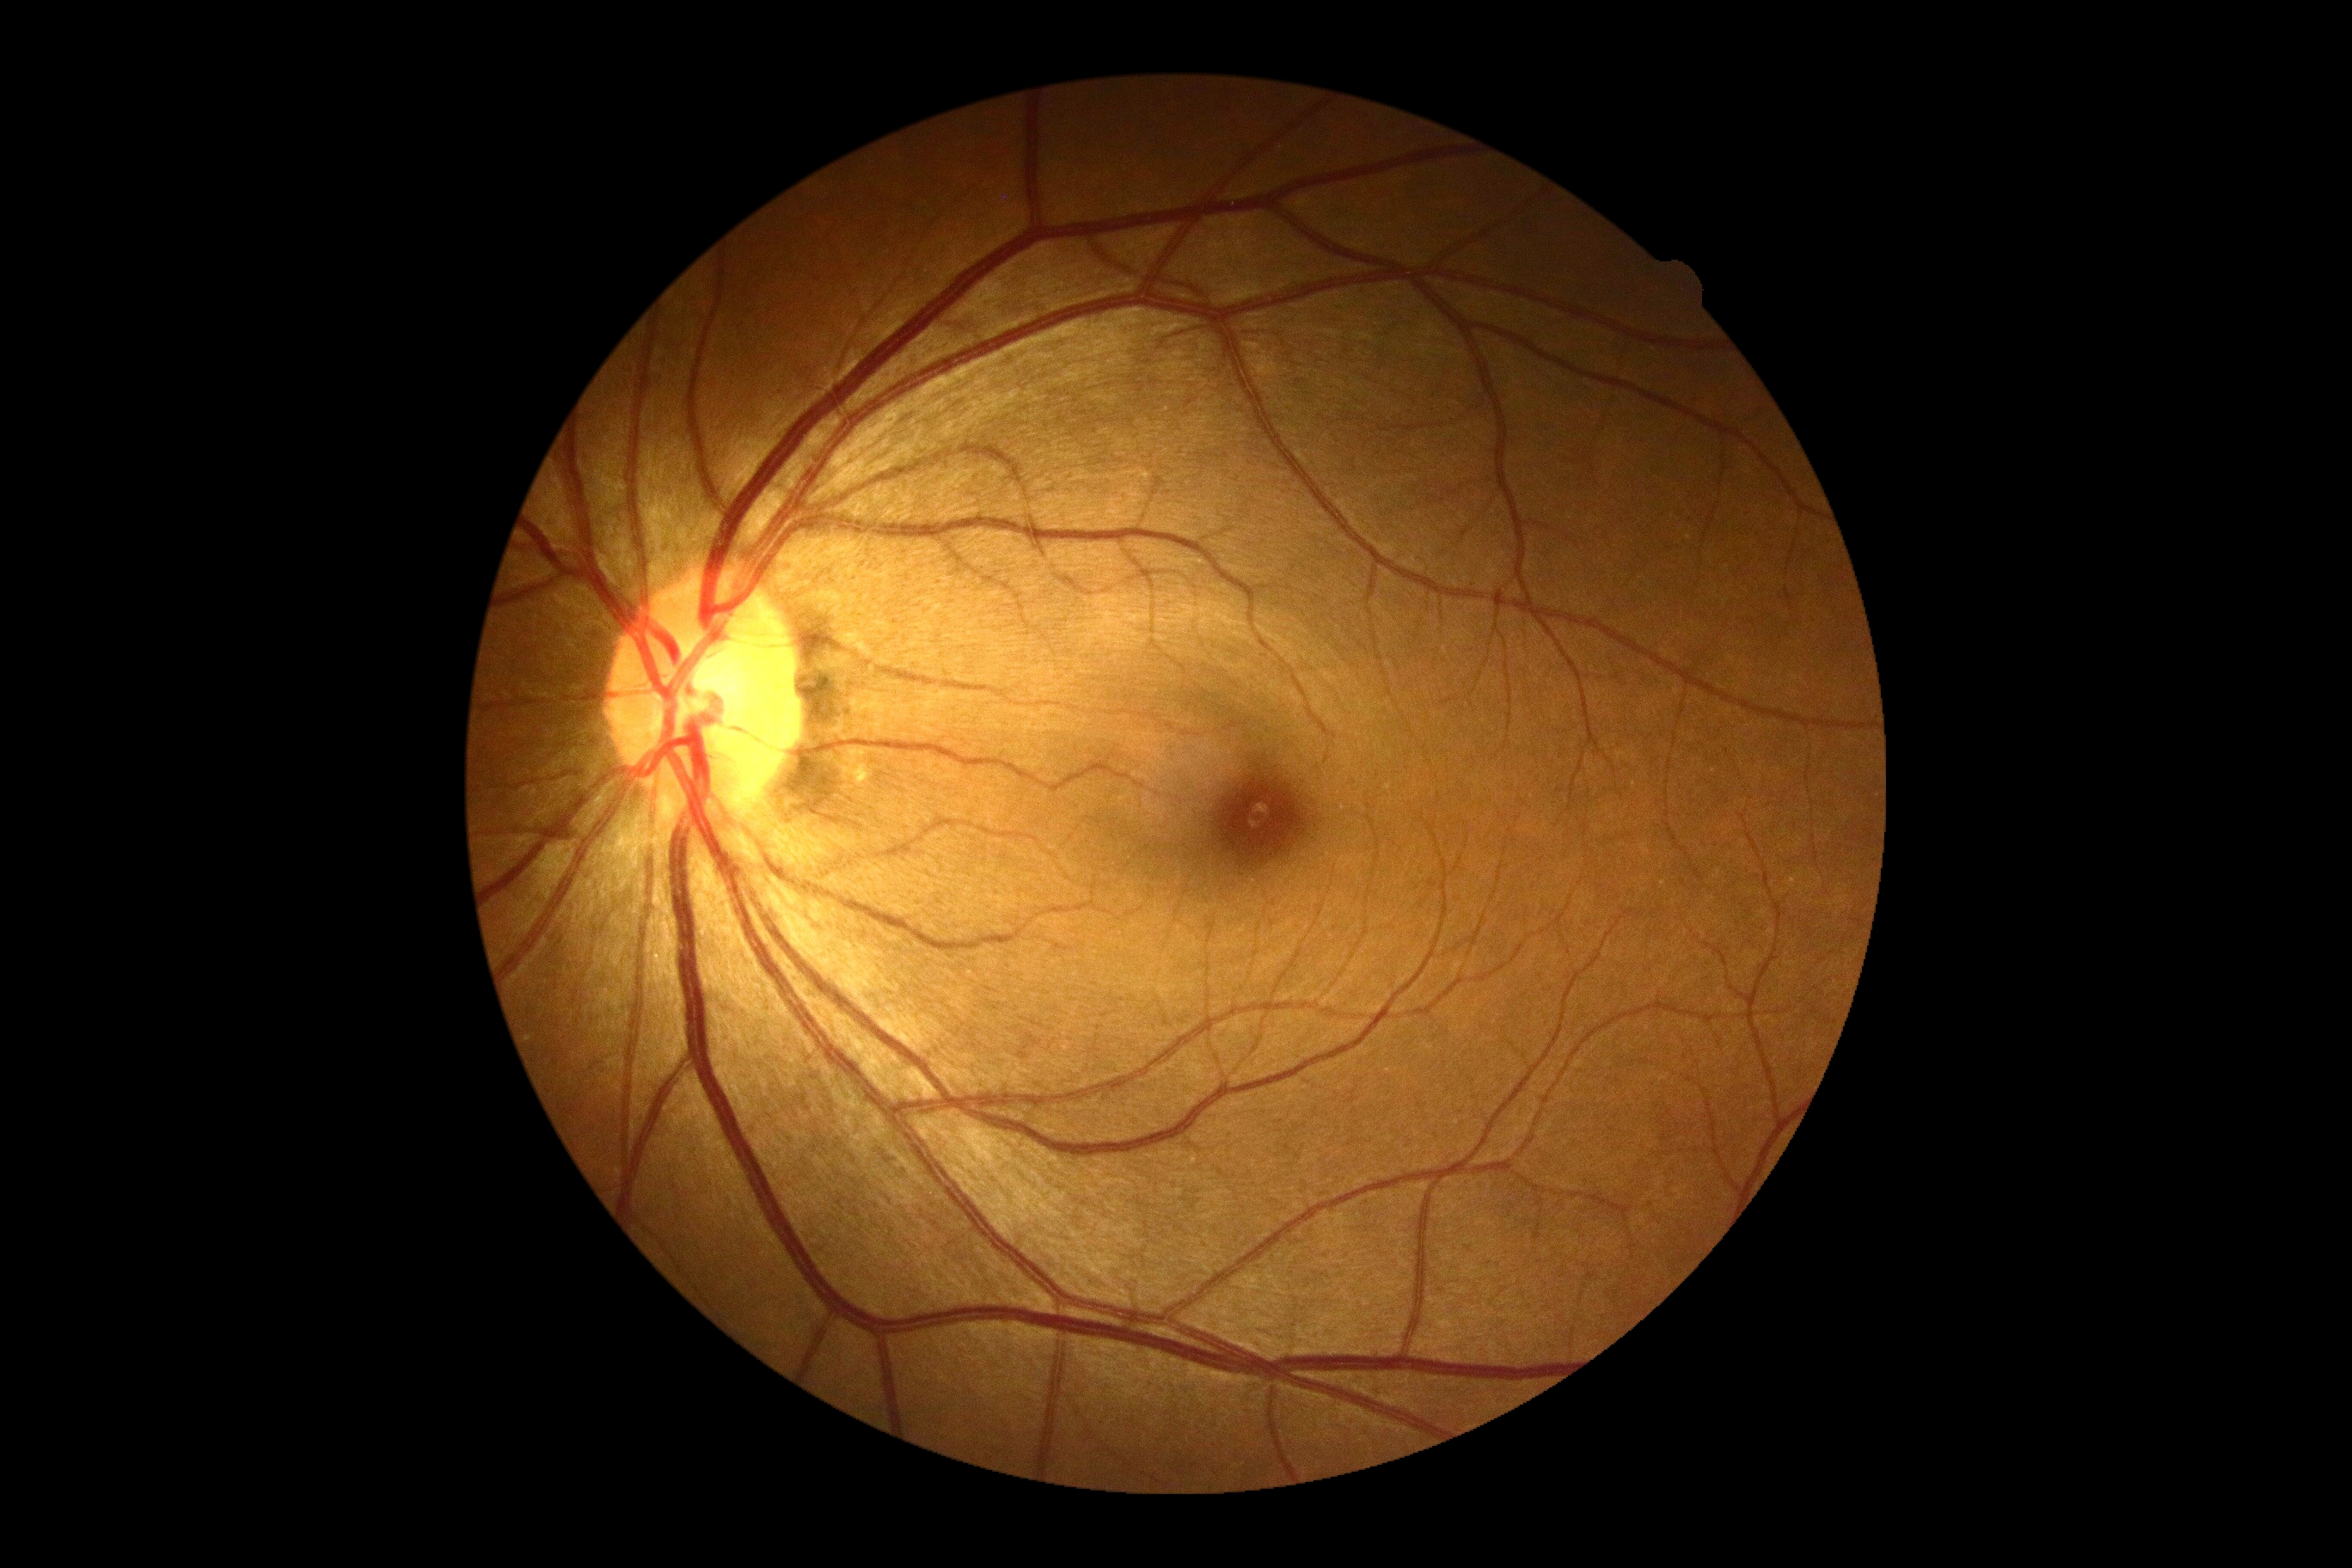 retinopathy grade@0.